Retinal fundus photograph · 45° field of view: 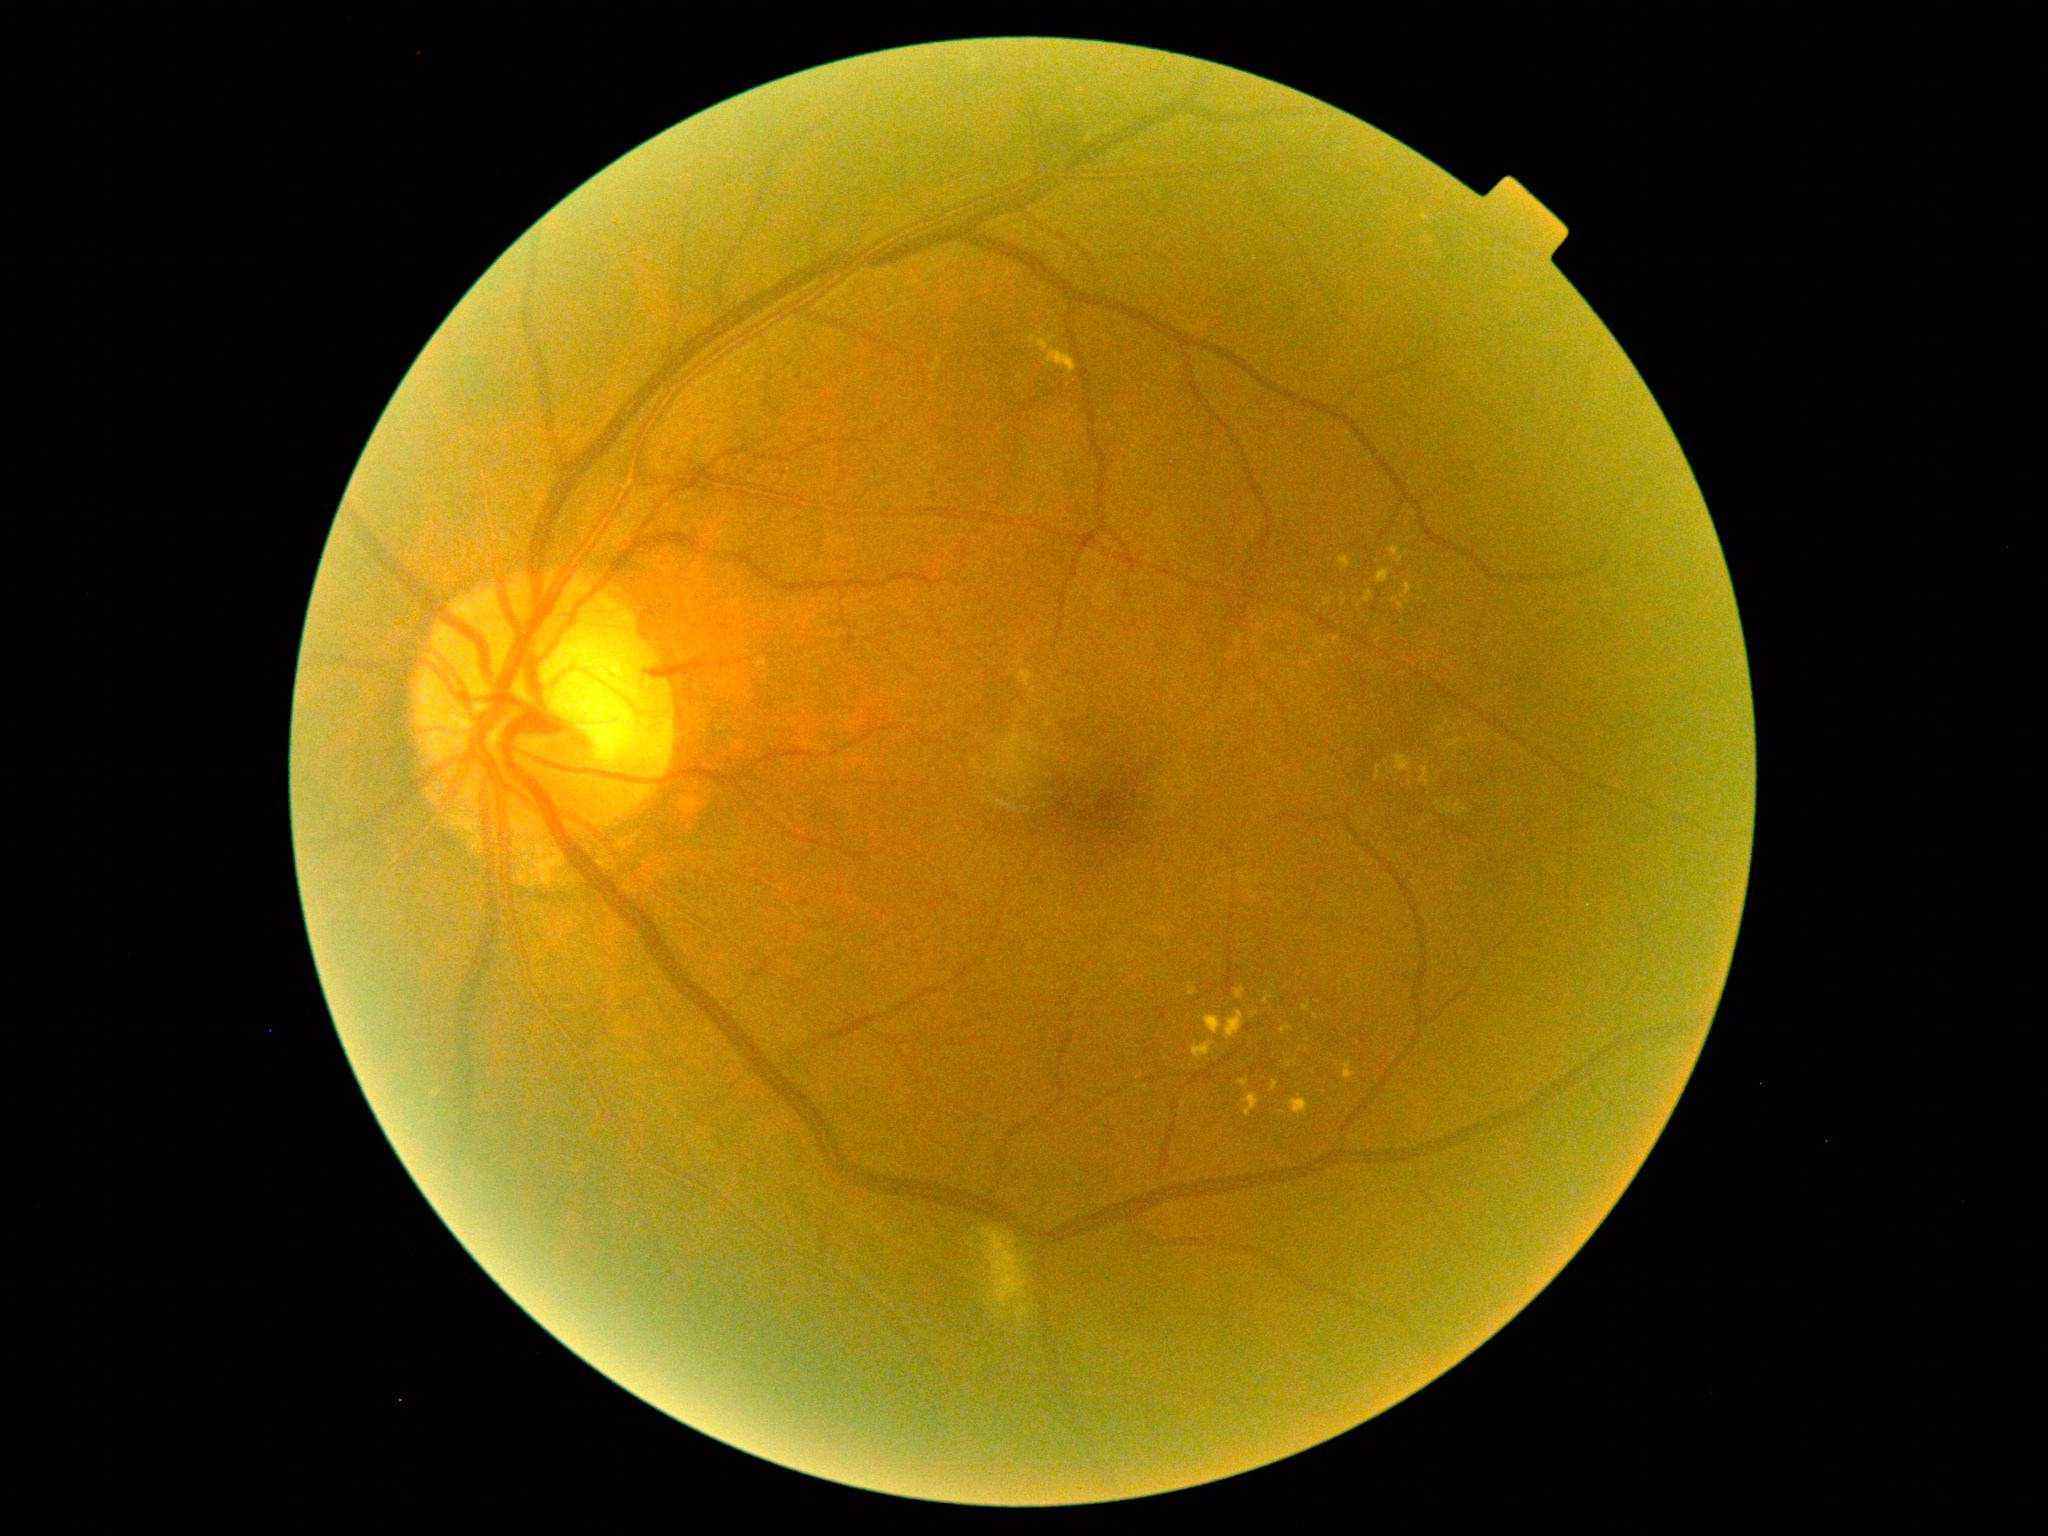

– DR class — non-proliferative diabetic retinopathy
– retinopathy — grade 2 — more than just microaneurysms but less than severe NPDR